Camera: Topcon TRC-50DX · 50-degree field of view · 2228 by 1652 pixels · fundus photo:
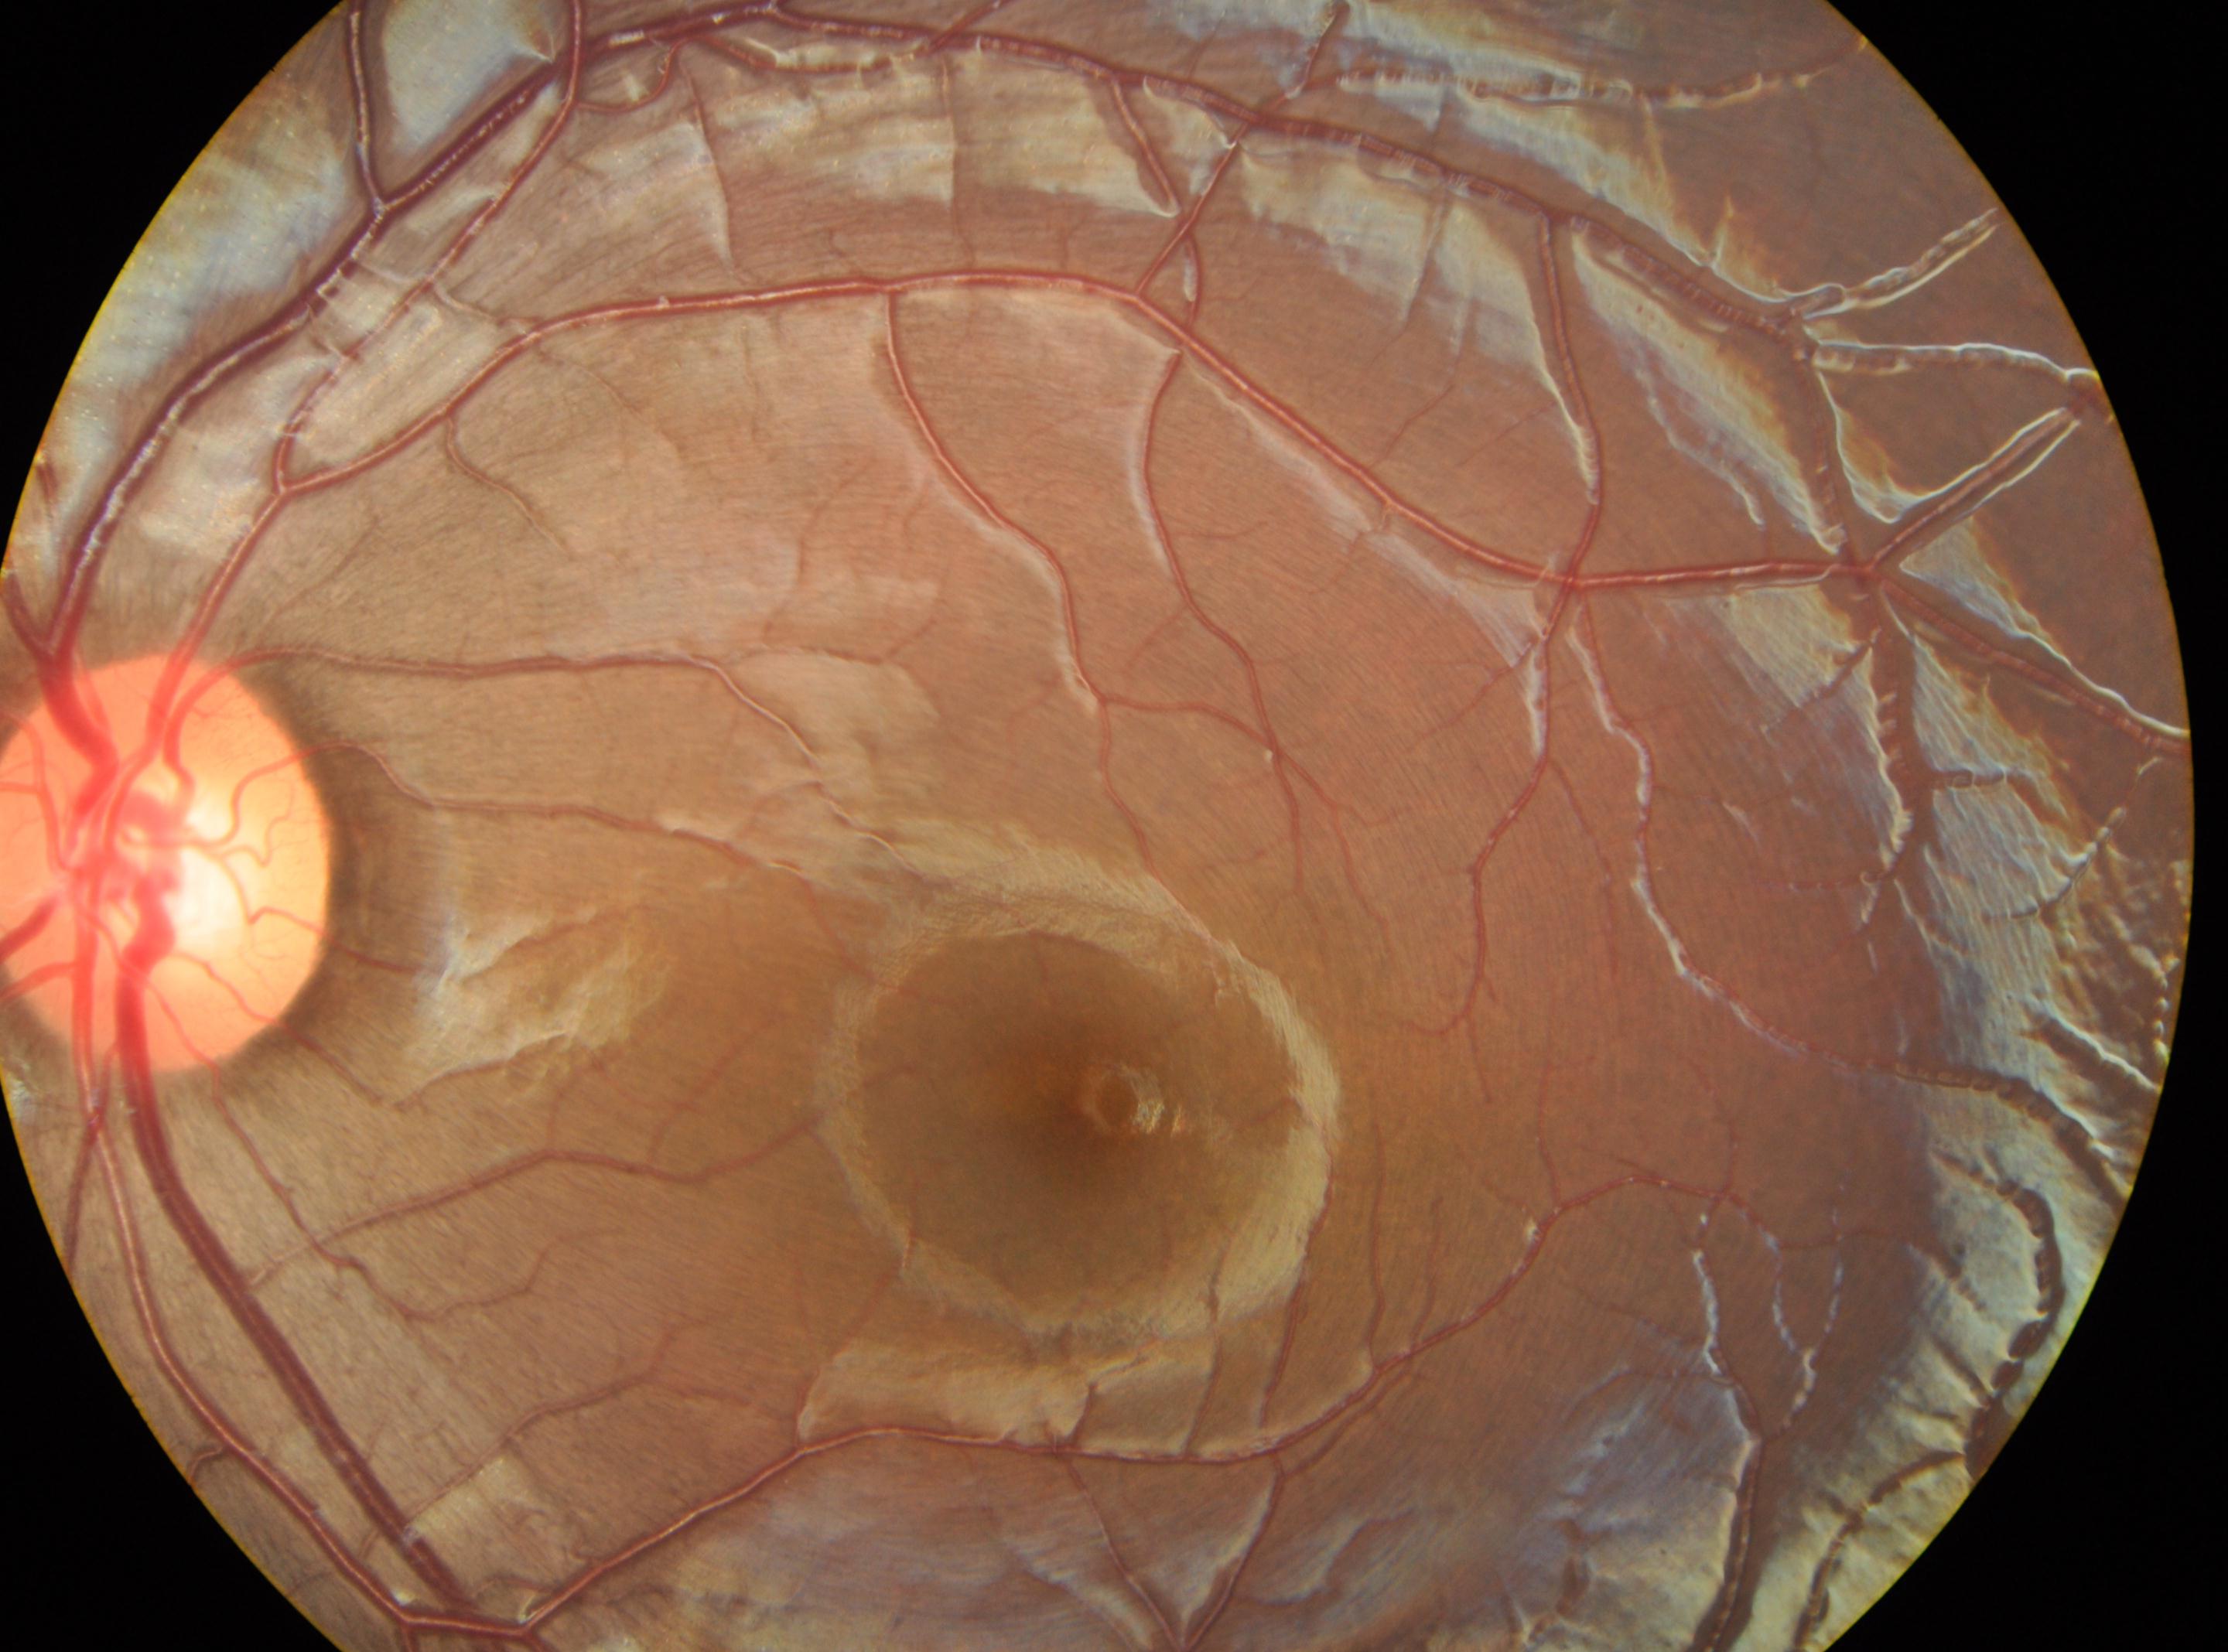
Optic disc center: x=172, y=861.
The fovea is at x=1077, y=1108.
Retinopathy grade is 0 (no apparent retinopathy).
Eye: the left eye.